Woman. 50 years old. Refraction: +0 -0.5 x 110: 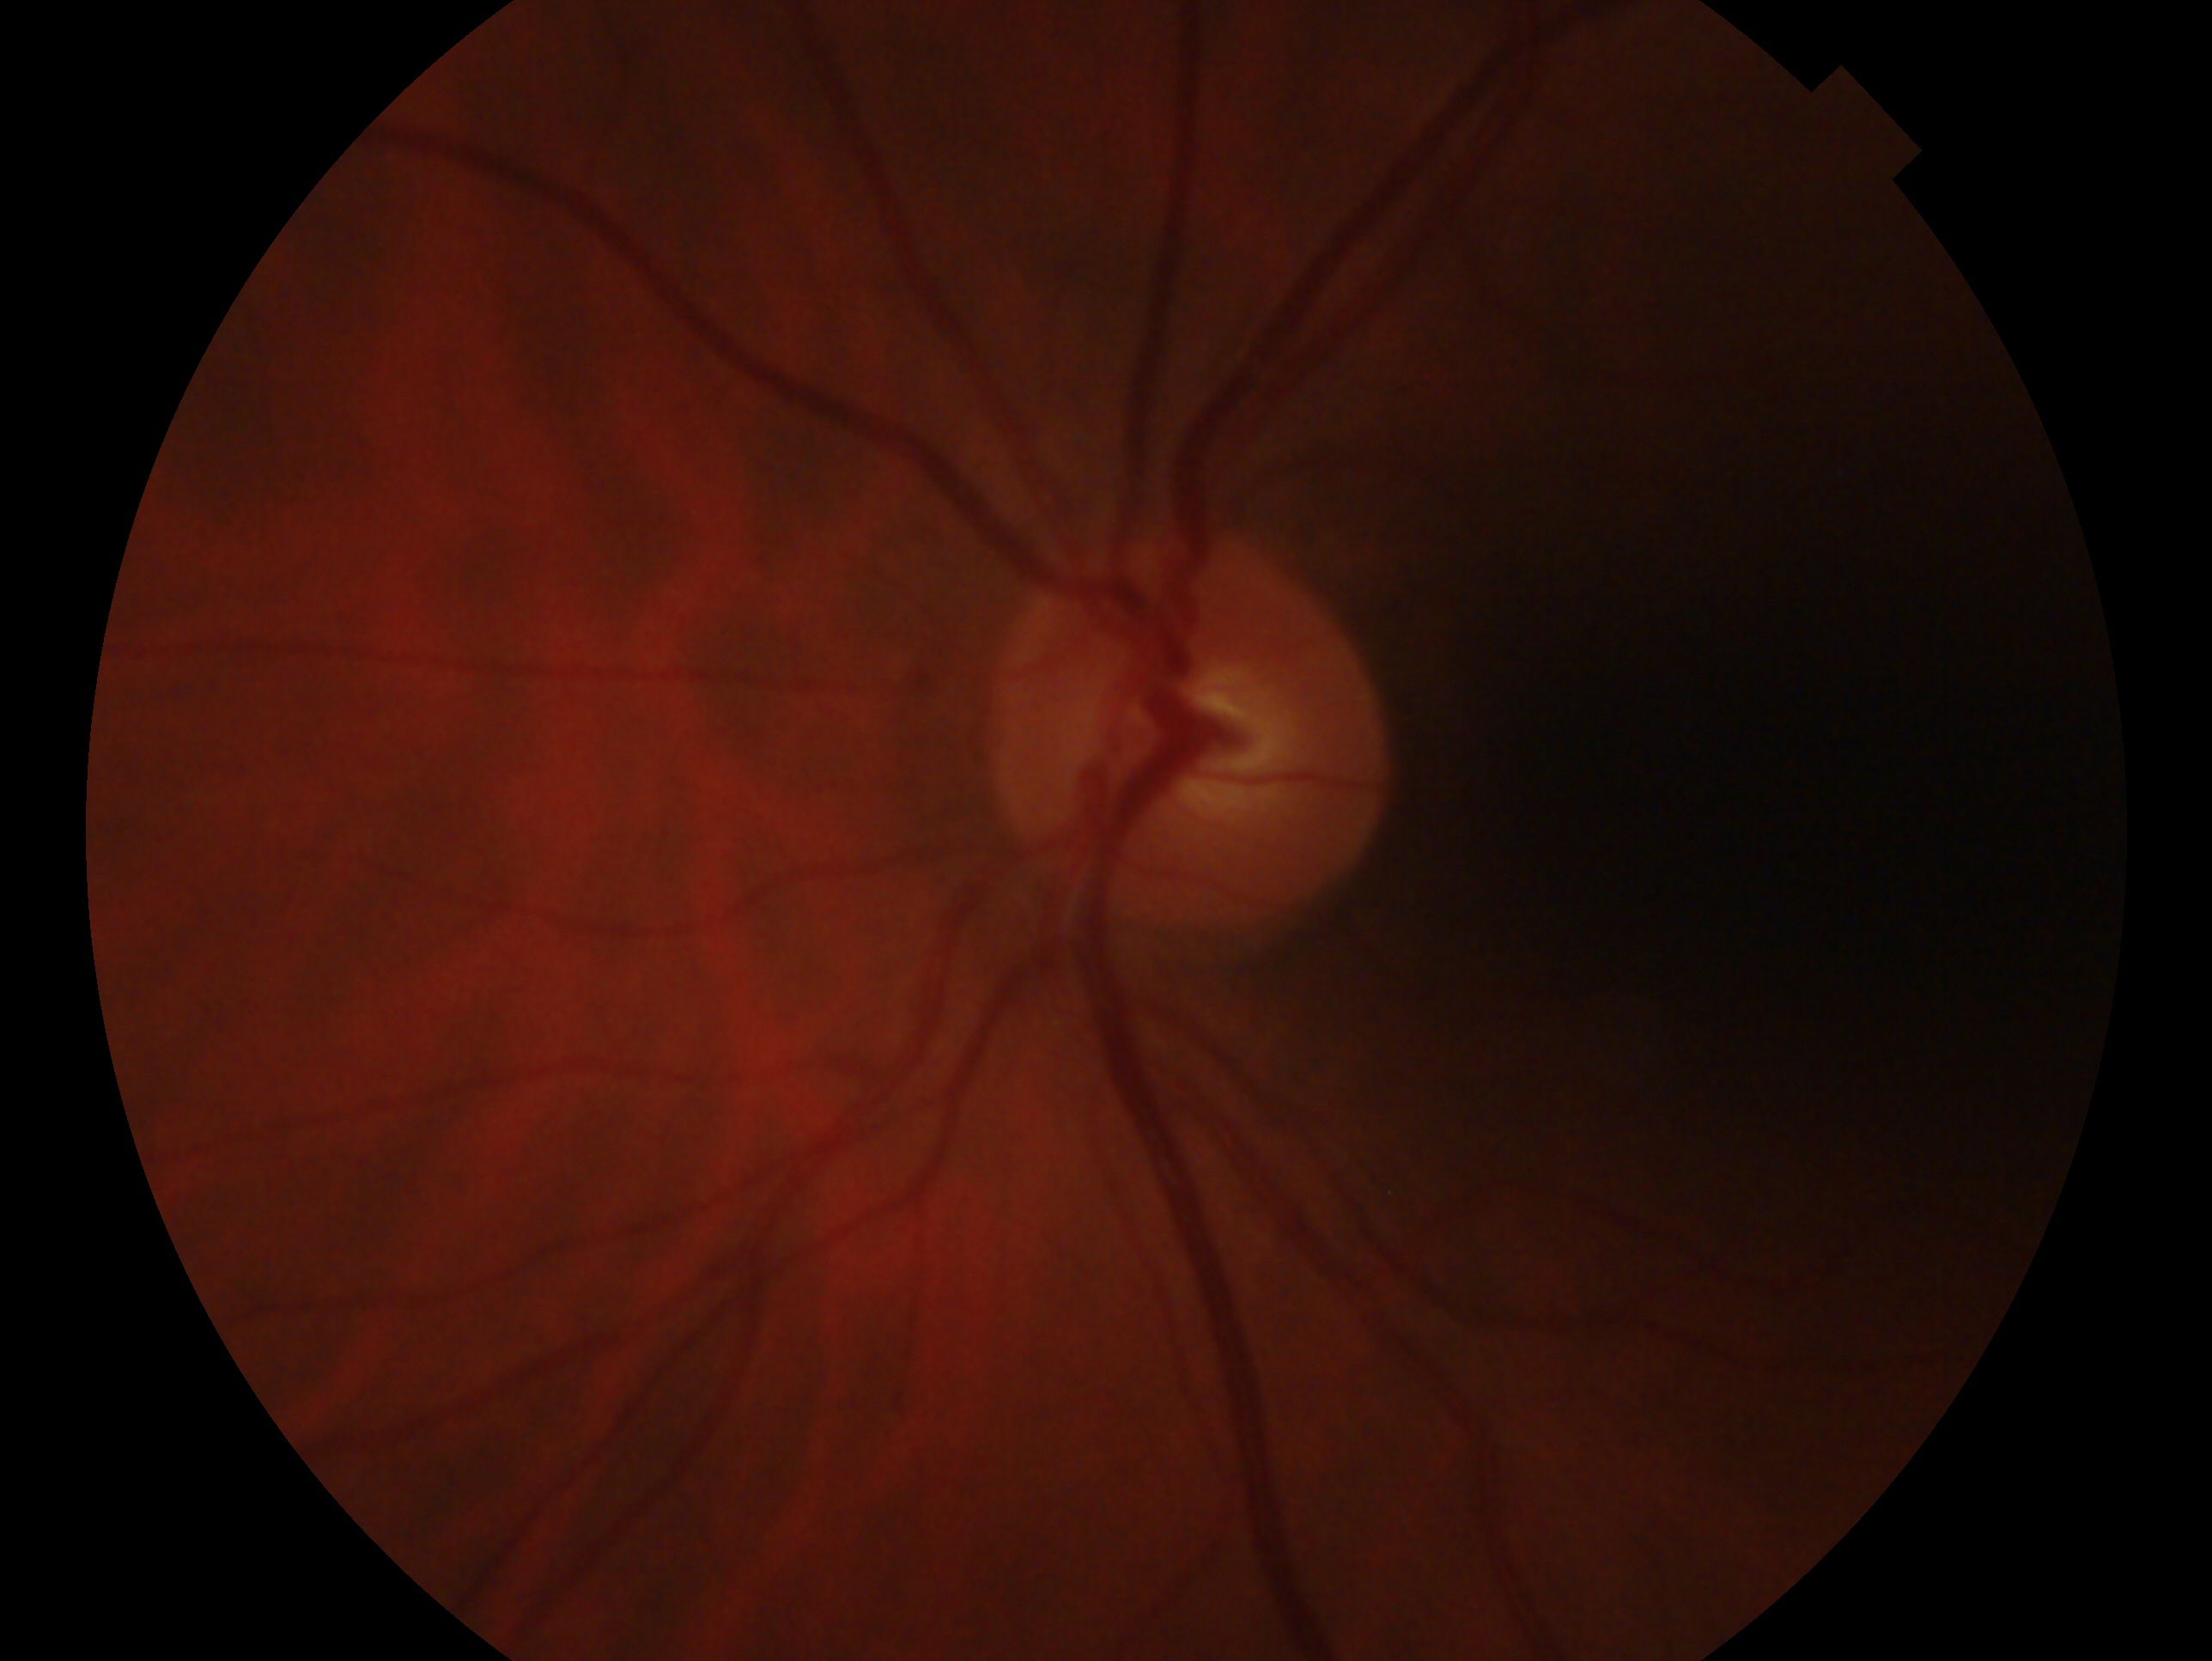
Findings:
- glaucoma assessment — no glaucomatous findings
- laterality — left eye